130° field of view (Clarity RetCam 3) · pediatric wide-field fundus photograph · 640x480px — 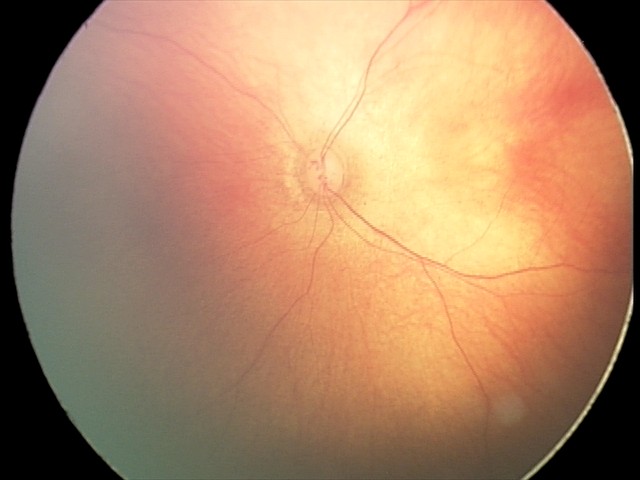 Examination diagnosed as retinal hemorrhages.